848 x 848 pixels. Without pupil dilation:
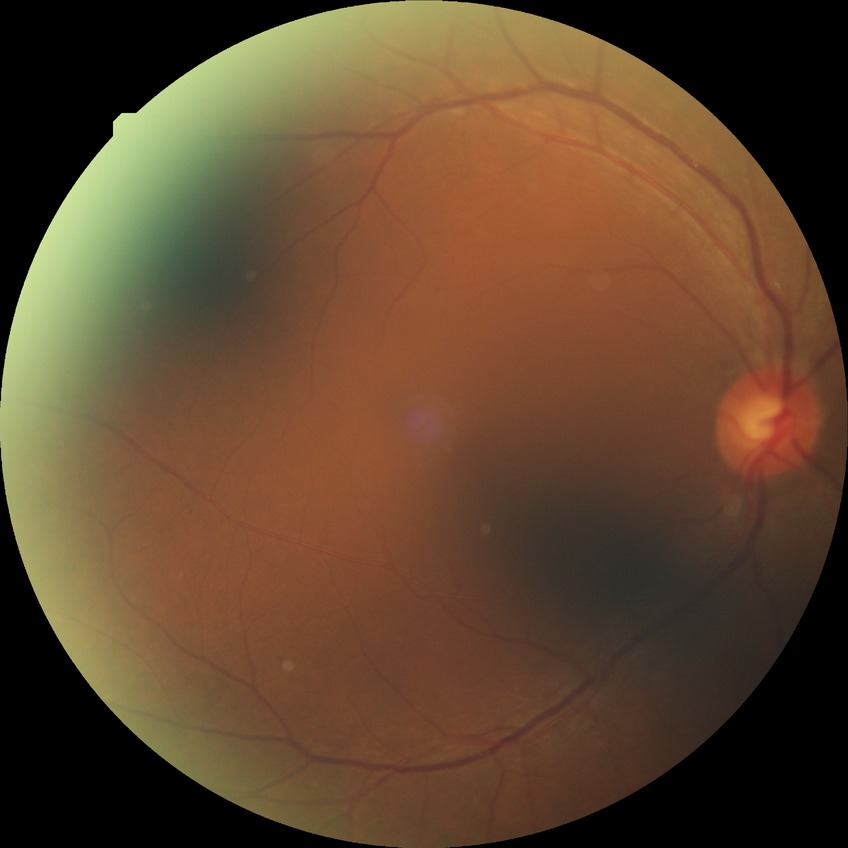

Diabetic retinopathy (DR): no diabetic retinopathy (NDR).